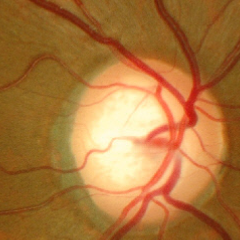
There is evidence of no glaucoma.